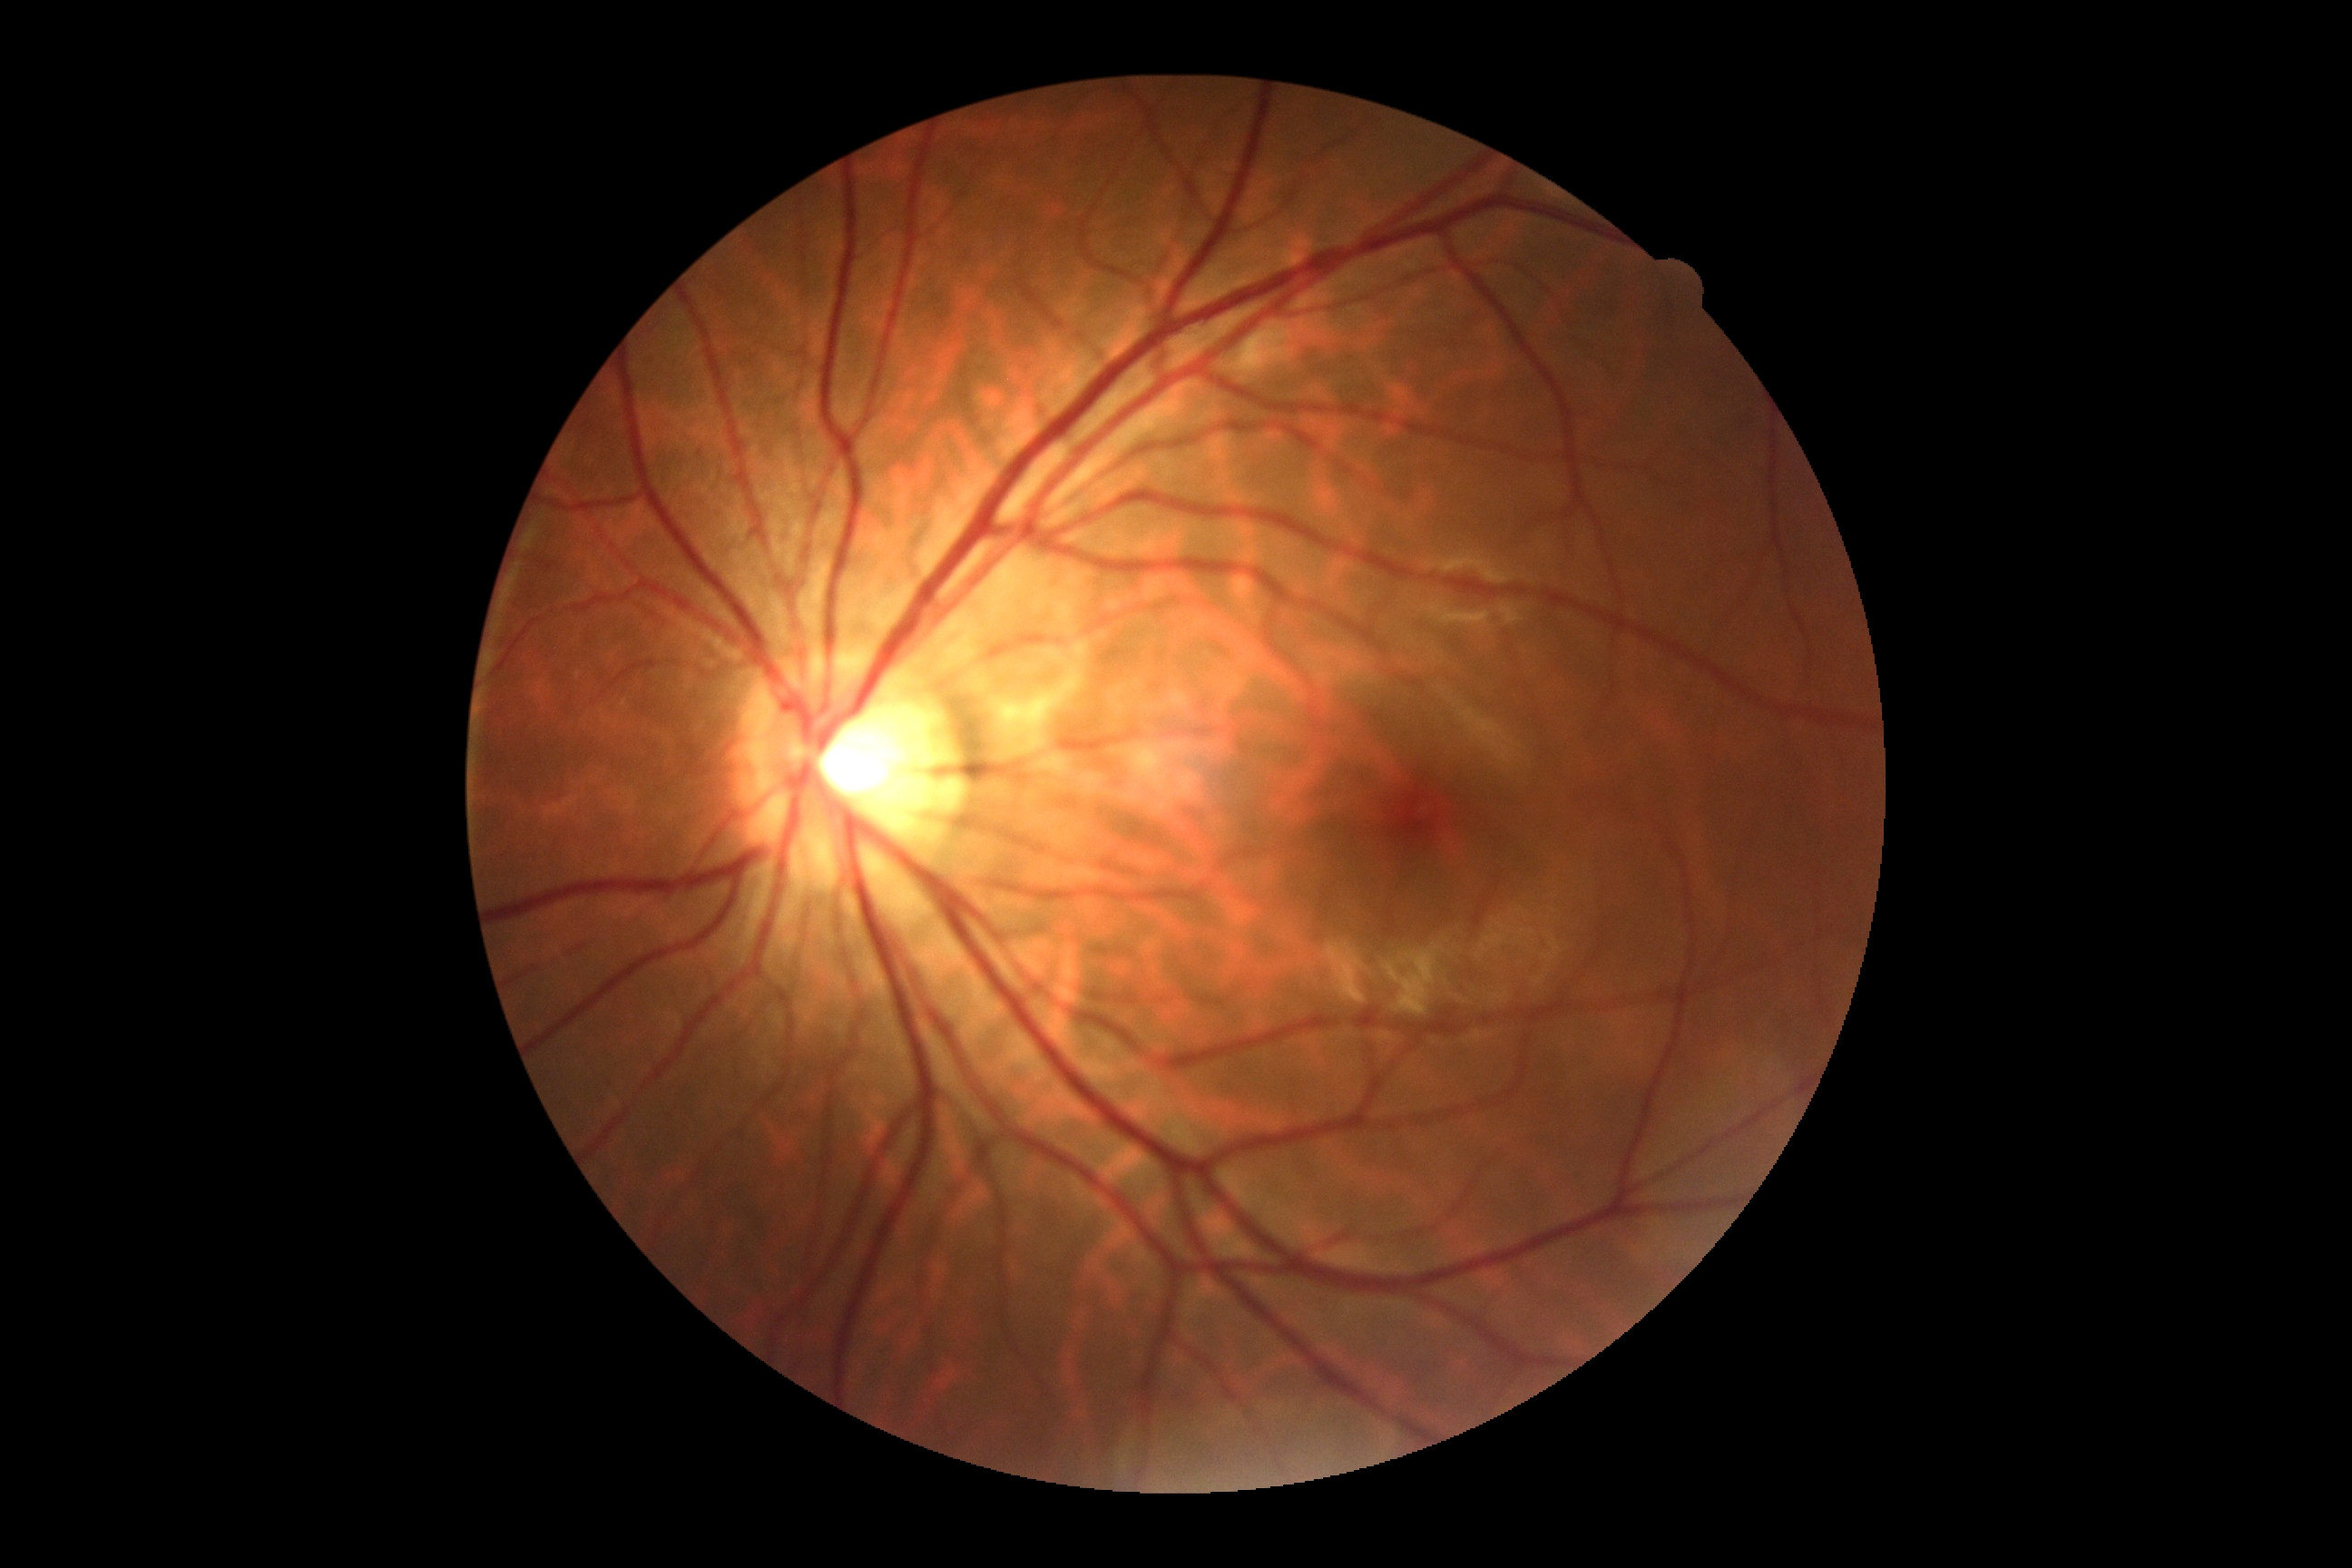
Diabetic retinopathy grade is no apparent retinopathy (0).